Wide-field contact fundus photograph of an infant — 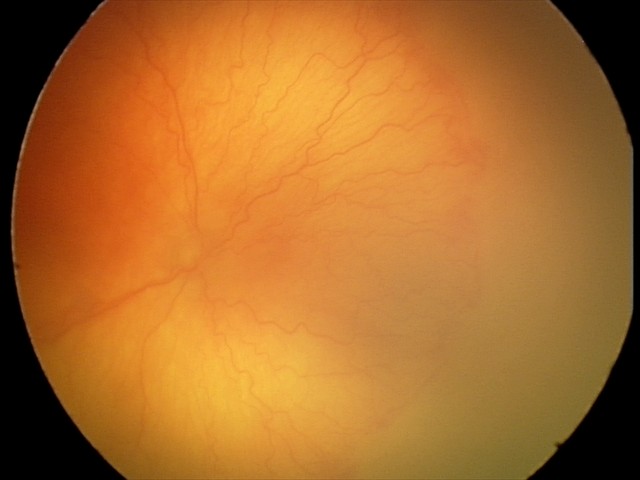 Q: What is the screening diagnosis?
A: A-ROP (aggressive ROP)
Q: Is plus disease present?
A: plus disease